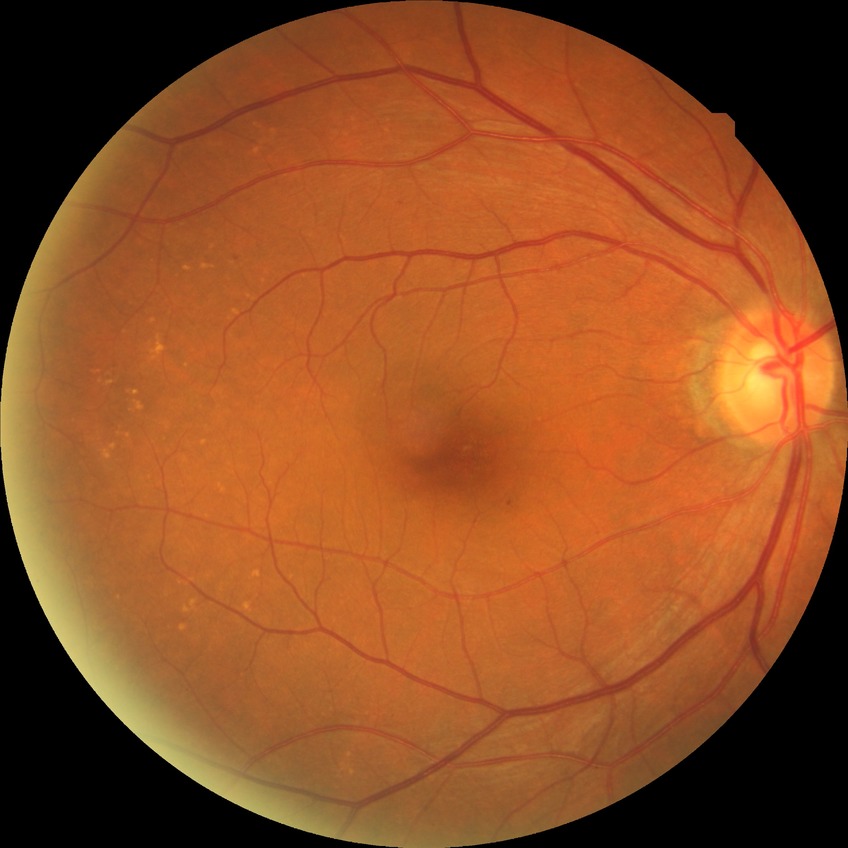
diabetic retinopathy (DR) = simple diabetic retinopathy (SDR).